Retinal fundus photograph · image size 2057x1545 · 45-degree field of view
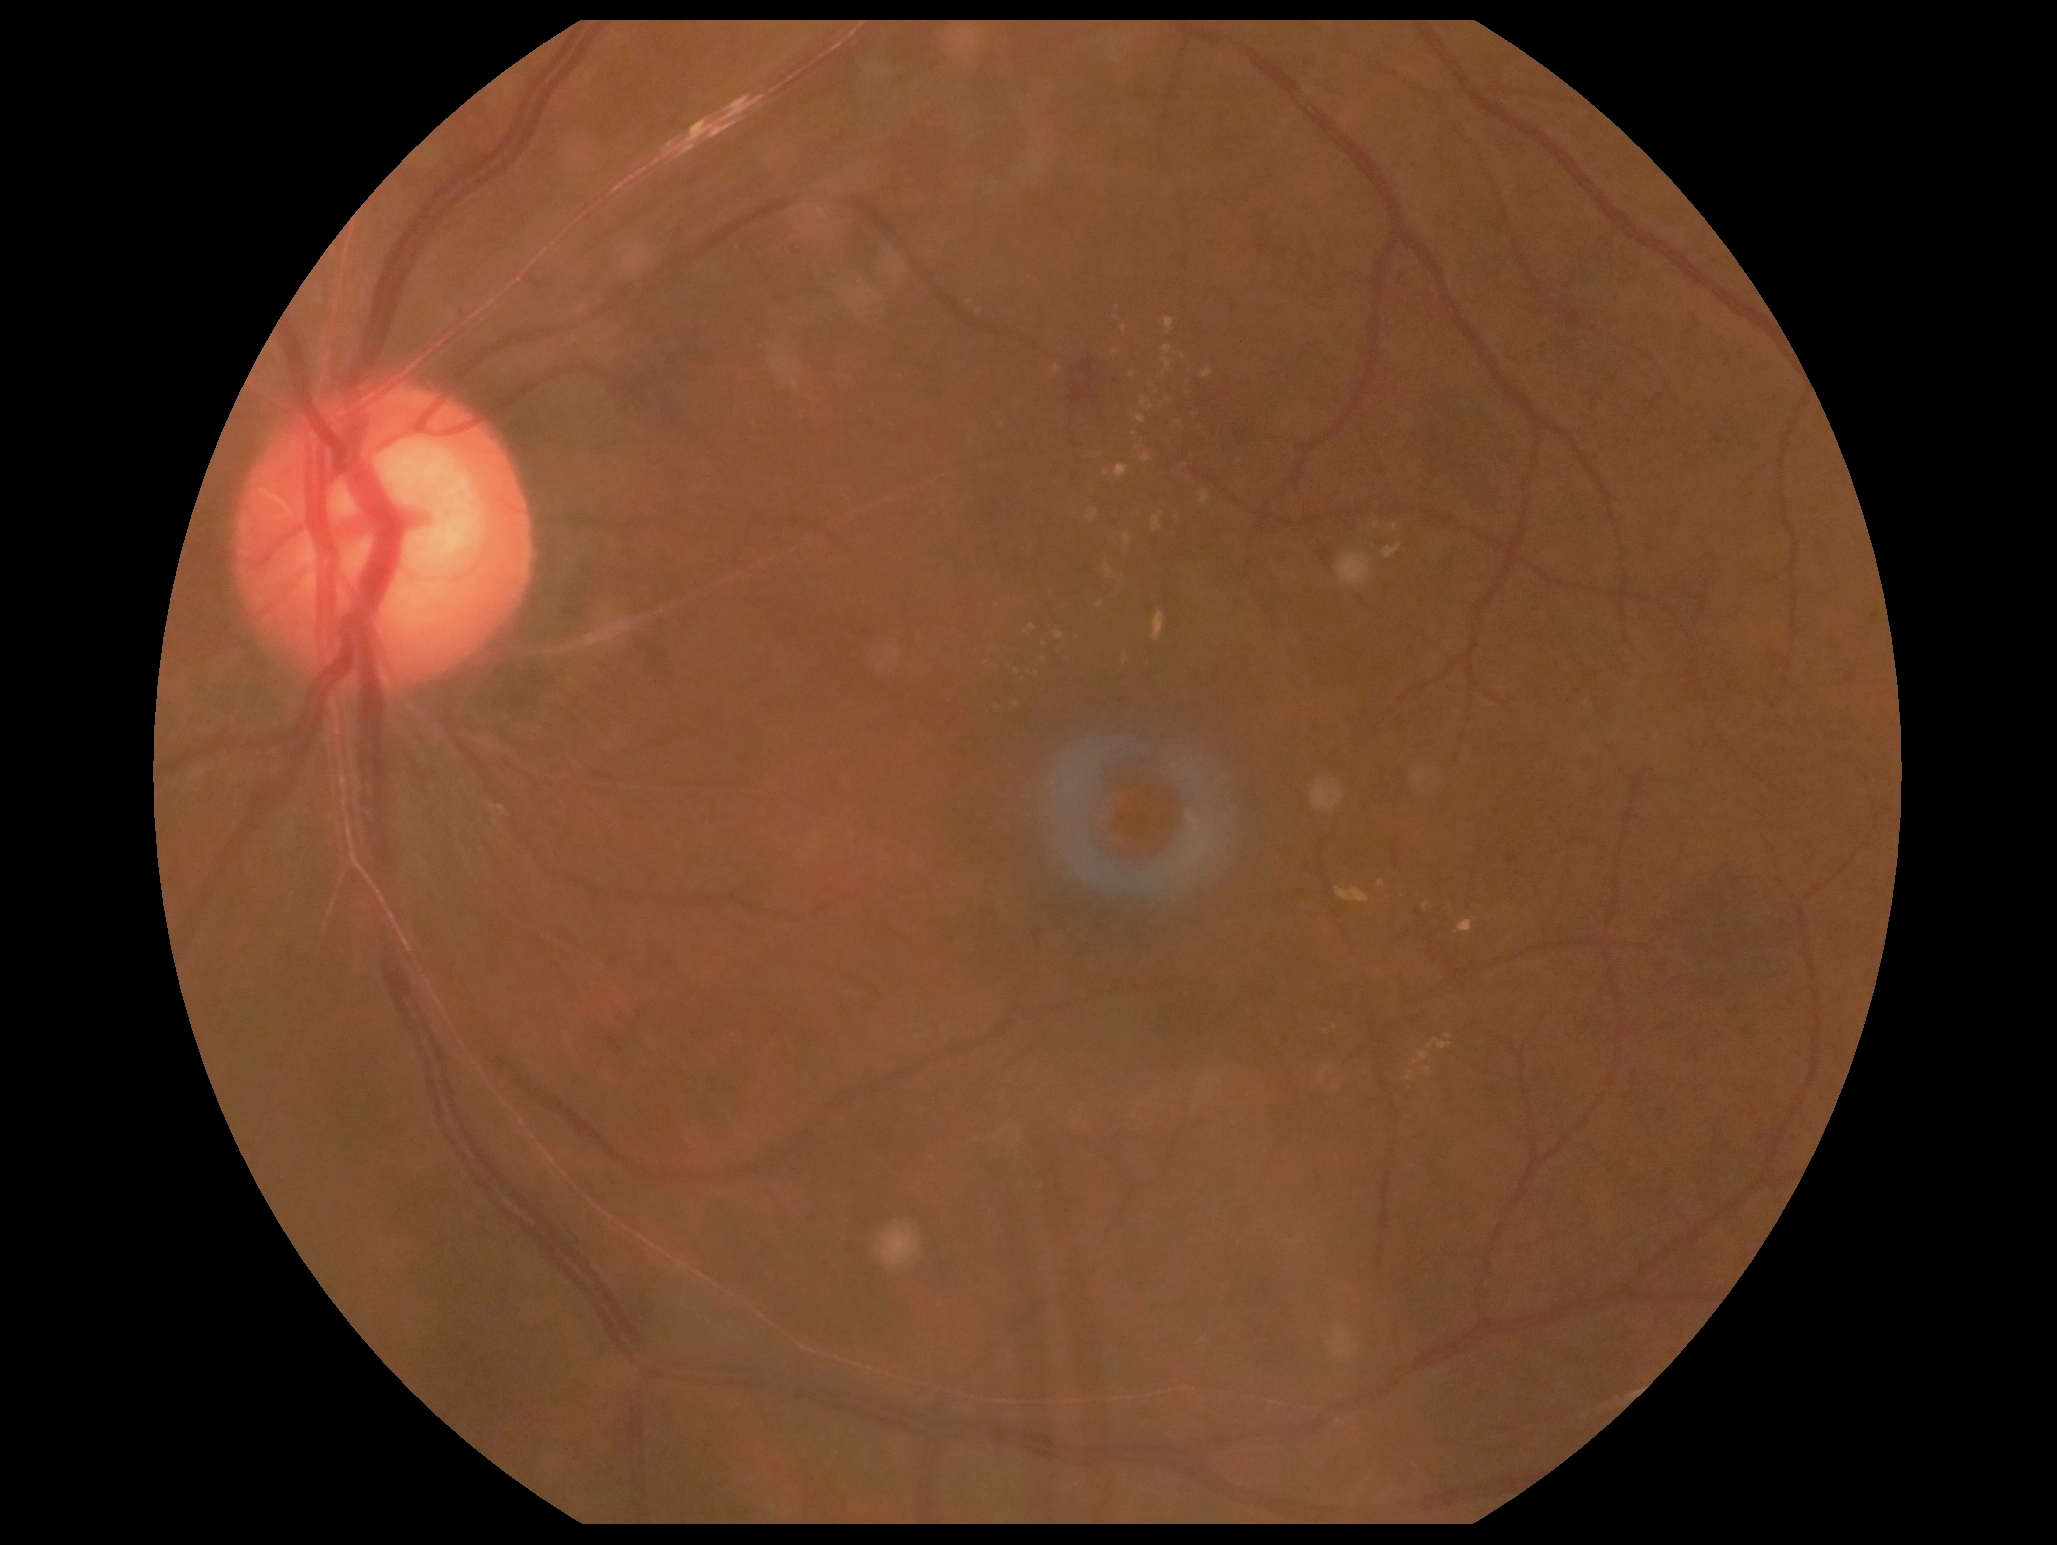

Retinopathy grade: 2 (moderate NPDR).